Fundus photo:
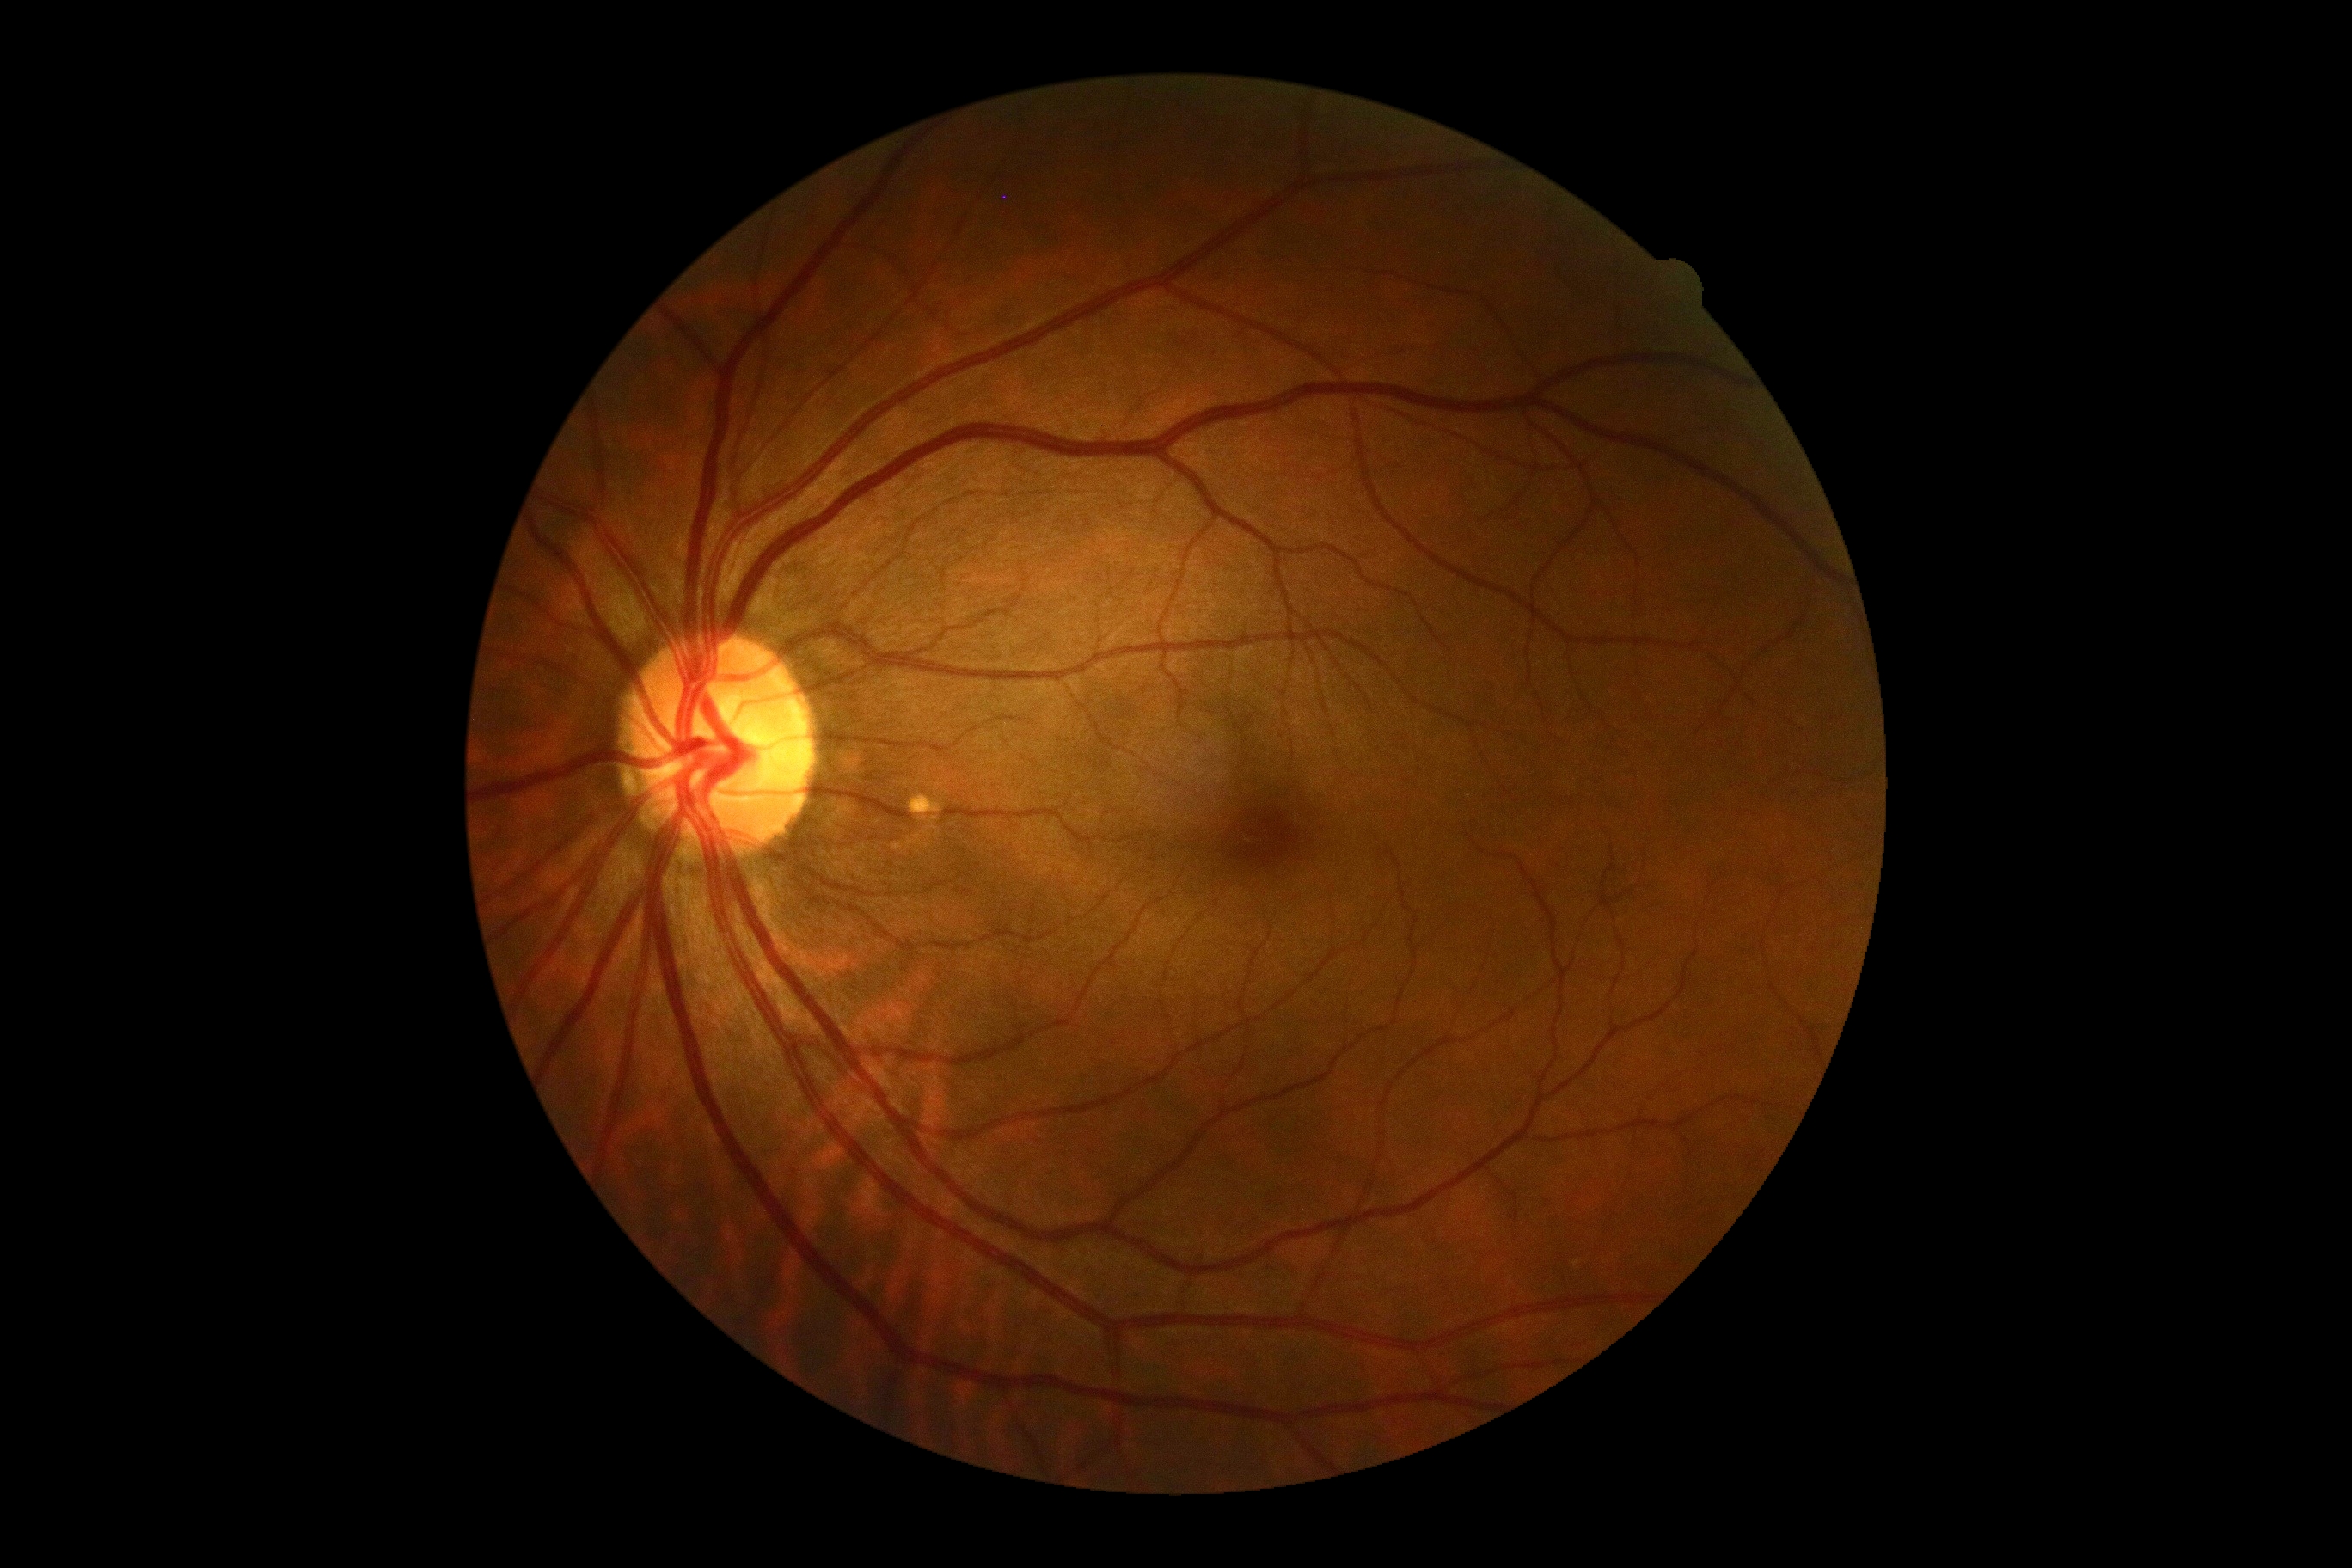

Findings:
* DR — 0